Color fundus photograph: 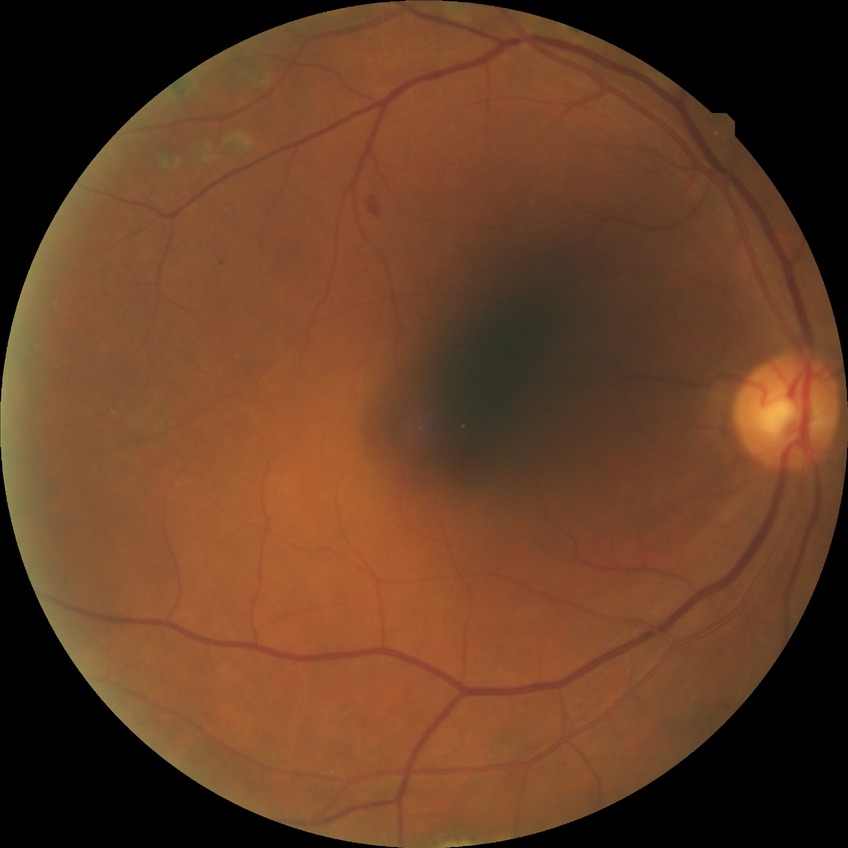

Diabetic retinopathy stage is proliferative diabetic retinopathy.